Posterior pole color fundus photograph. Image size 848x848. No pharmacologic dilation. Modified Davis grading. FOV: 45 degrees.
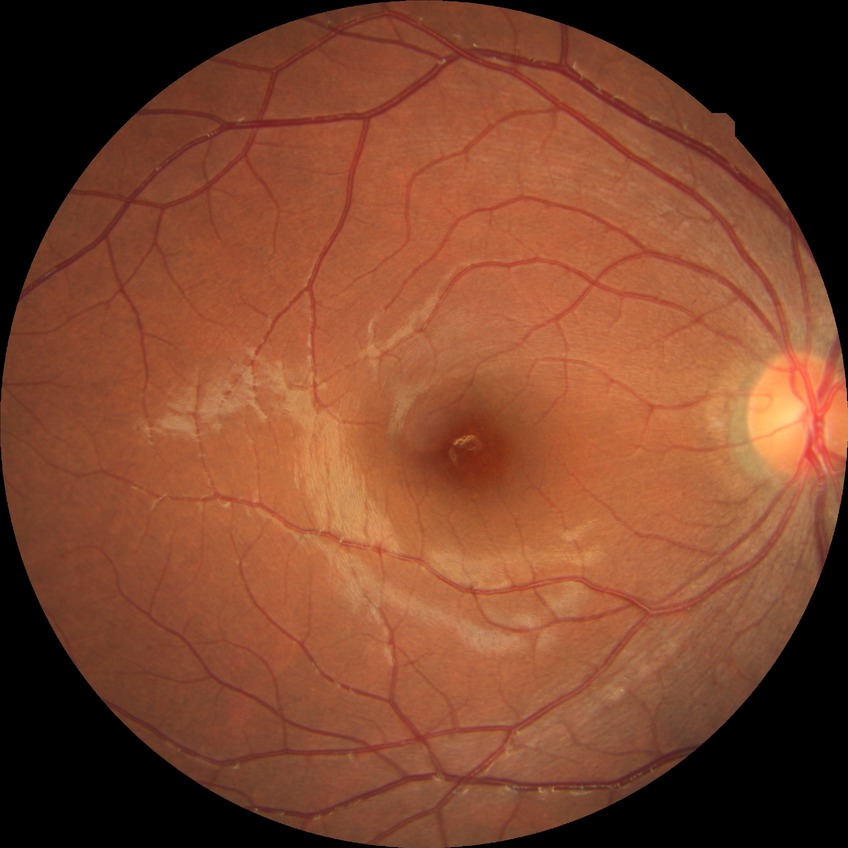

diabetic retinopathy grade: no diabetic retinopathy.